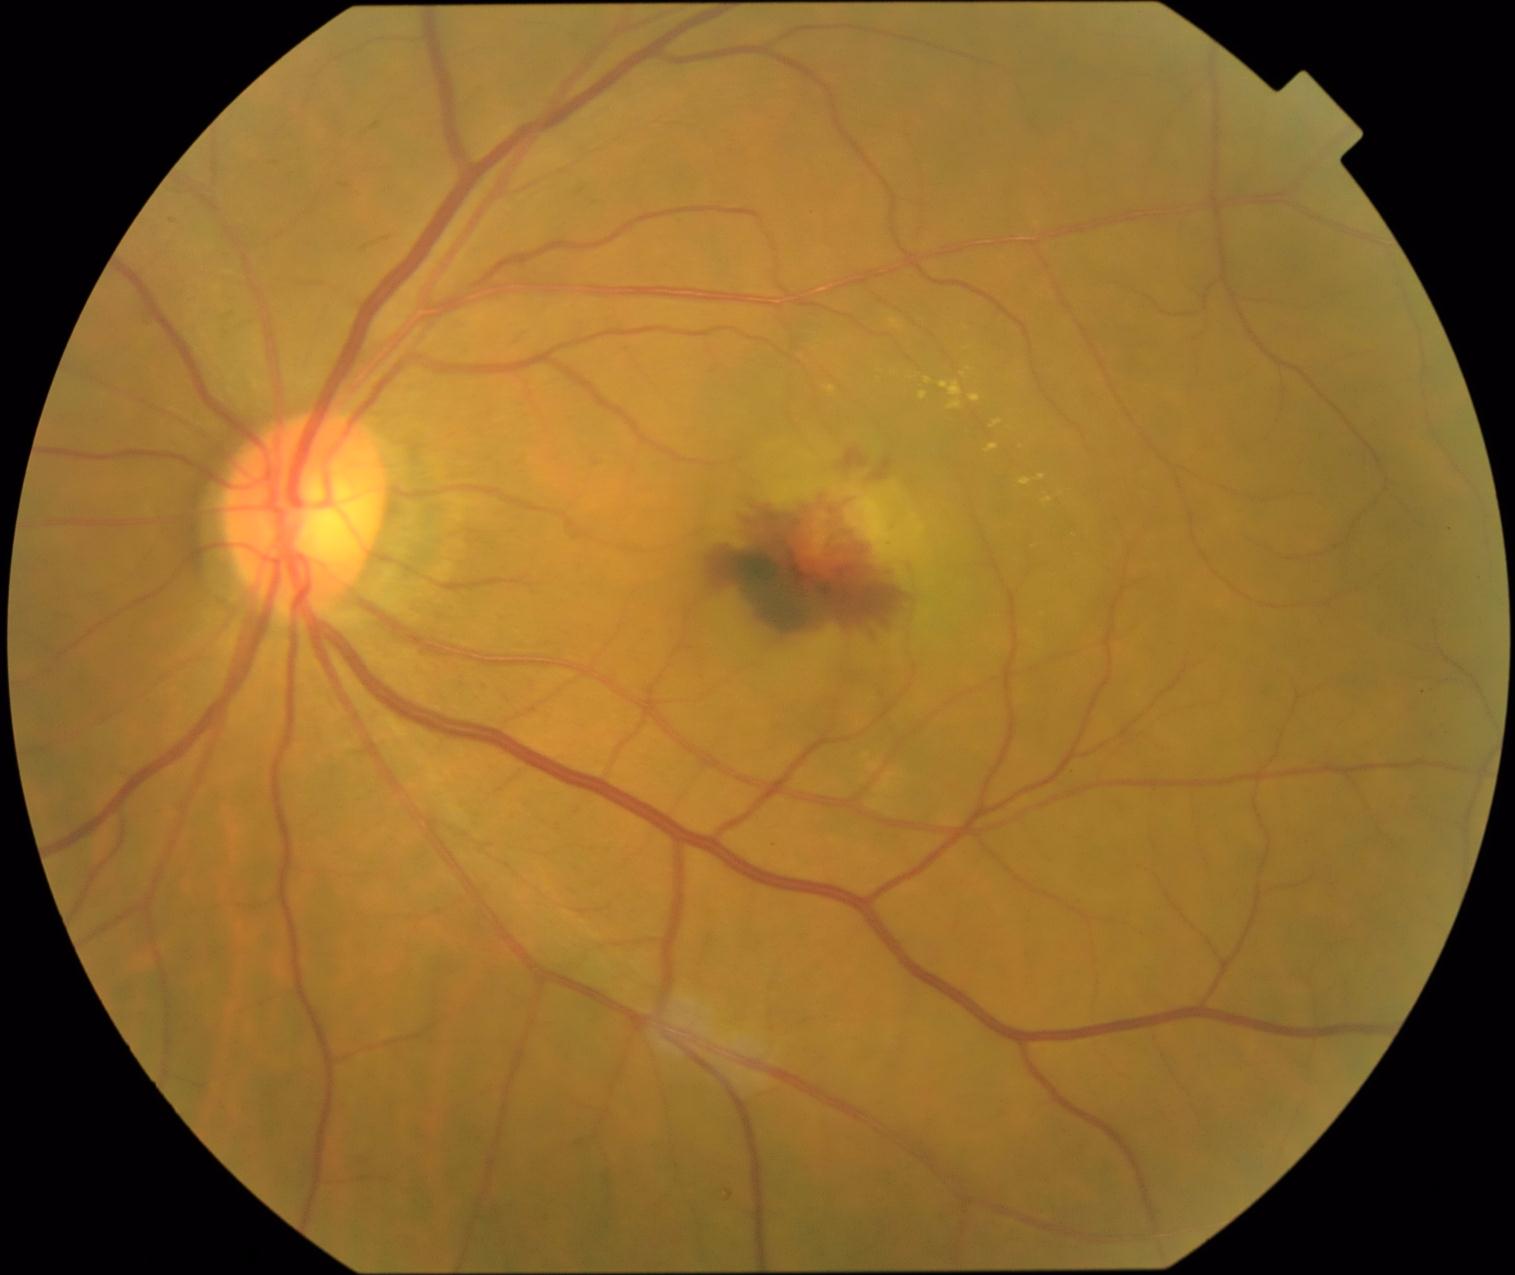
{
  "dr_grade": "grade 4 (PDR) — neovascularization and/or vitreous/pre-retinal hemorrhage"
}